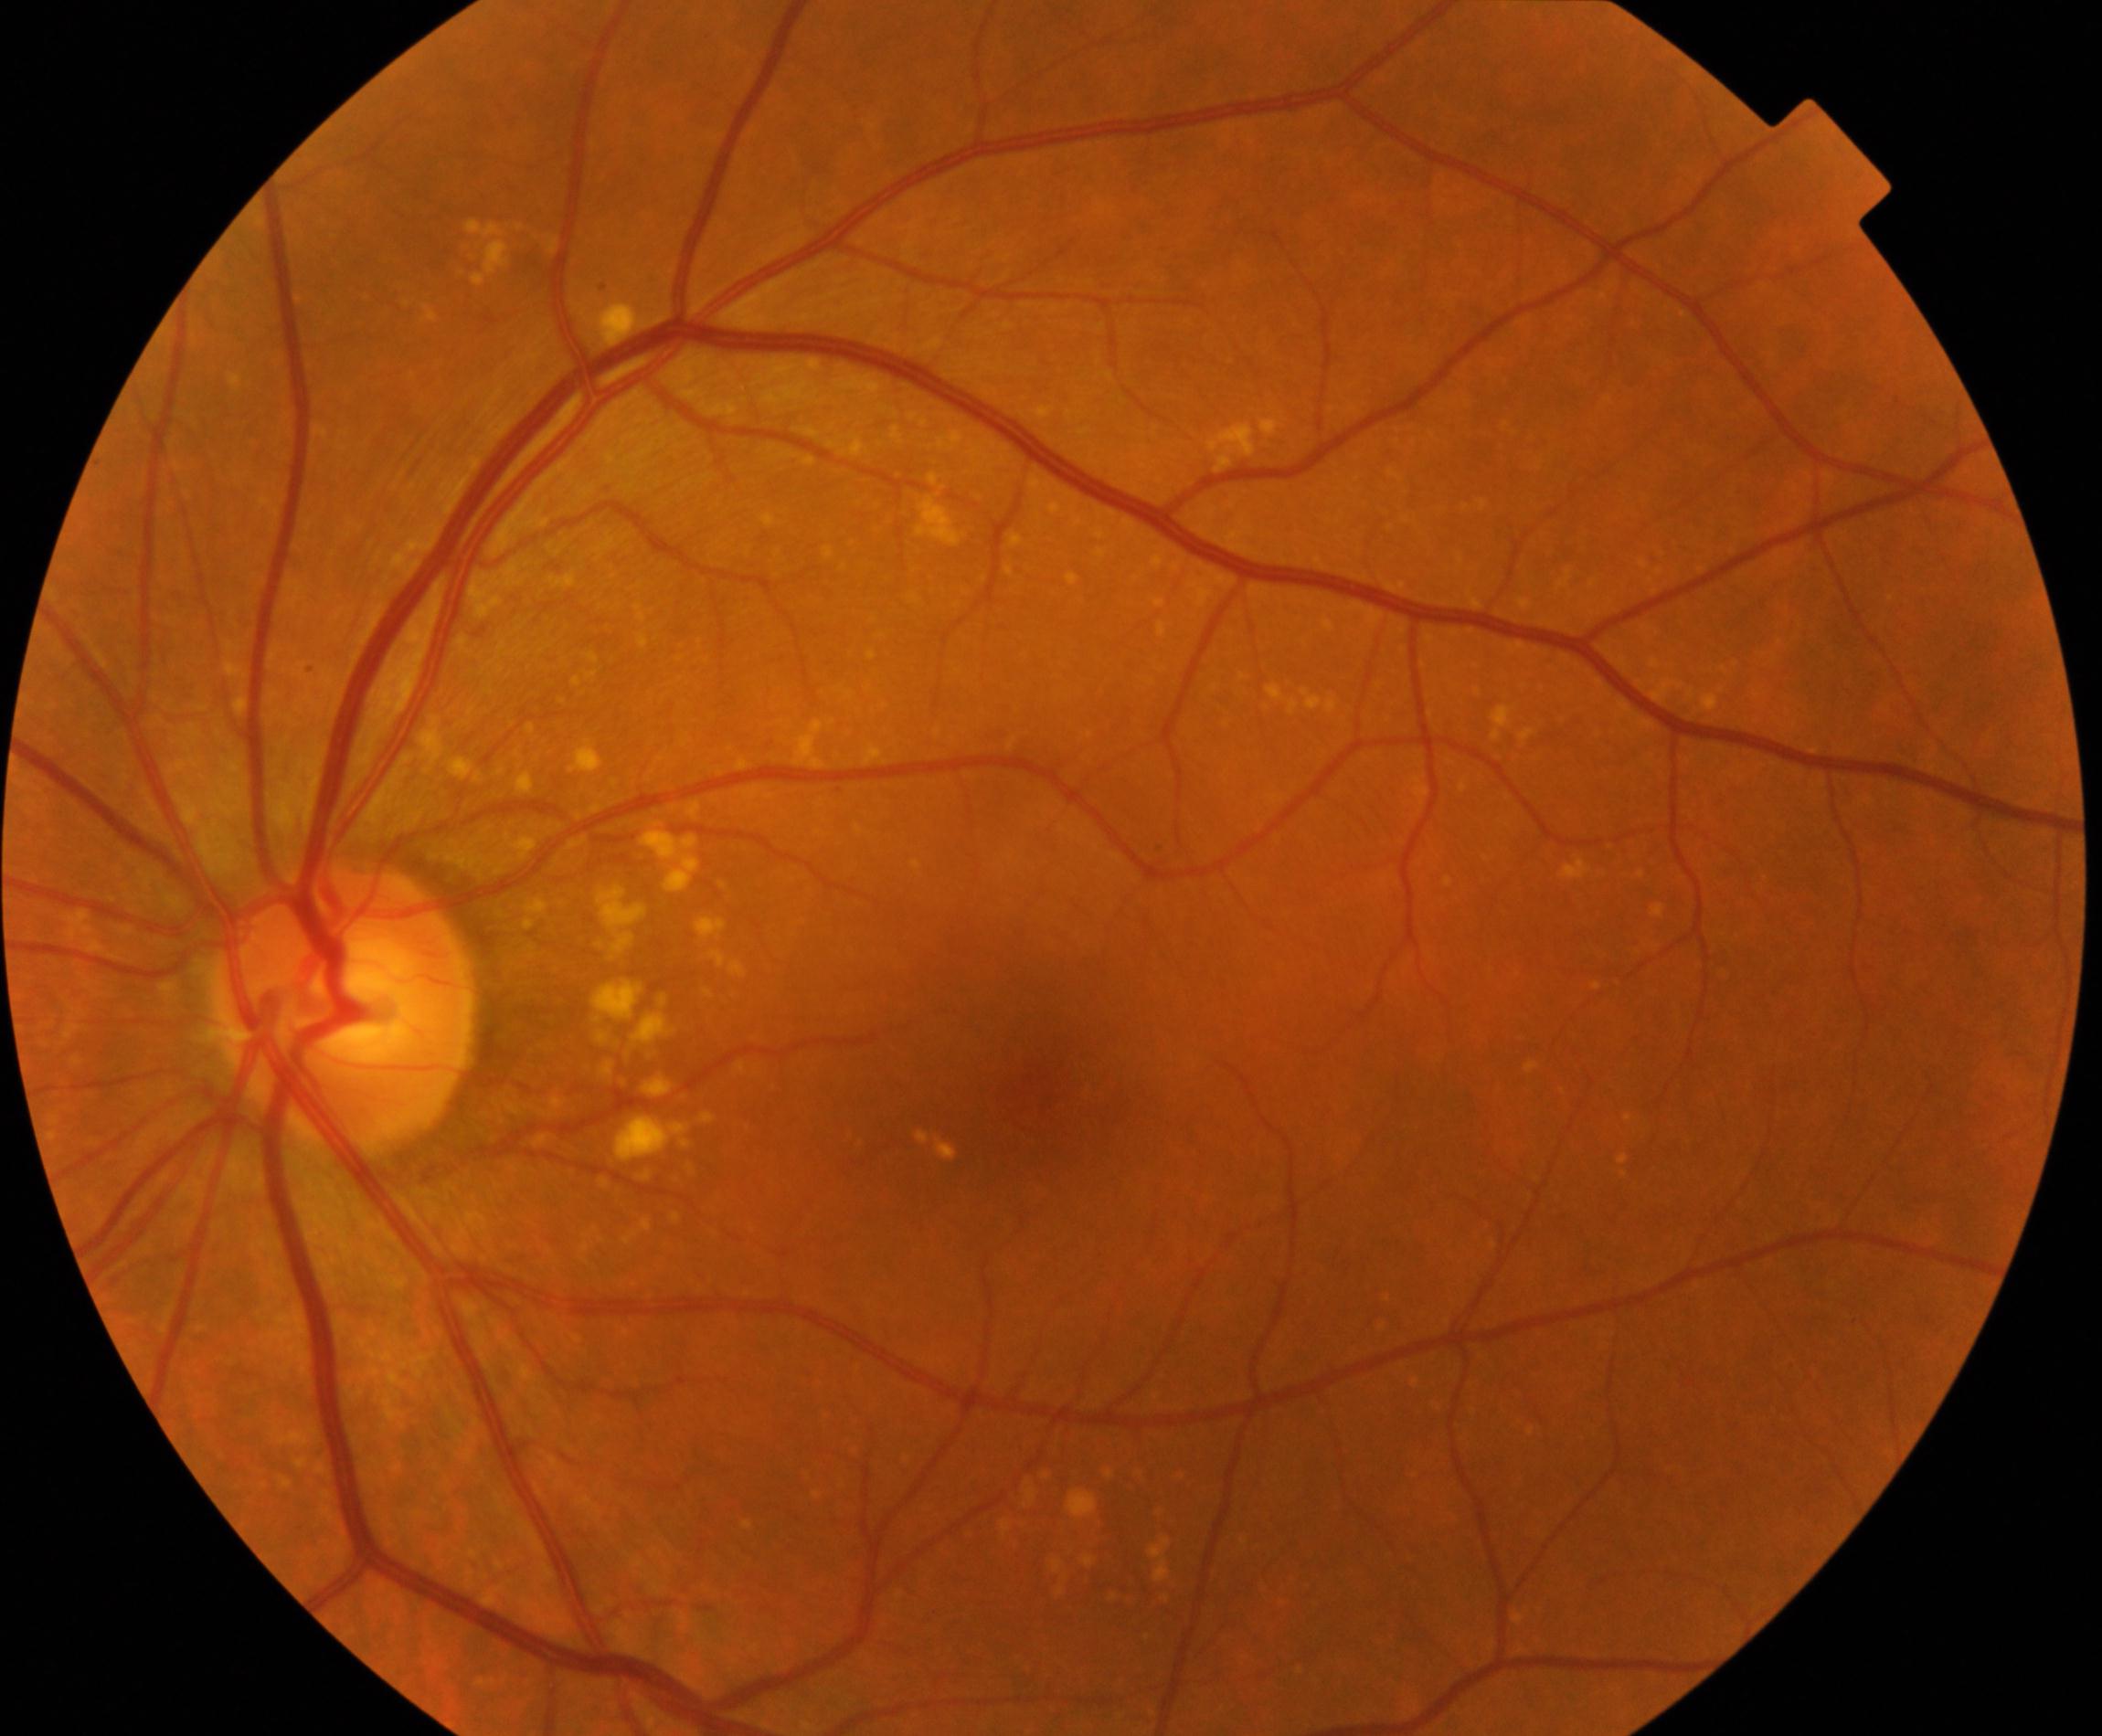

Classification: yellow-white spots or flecks.